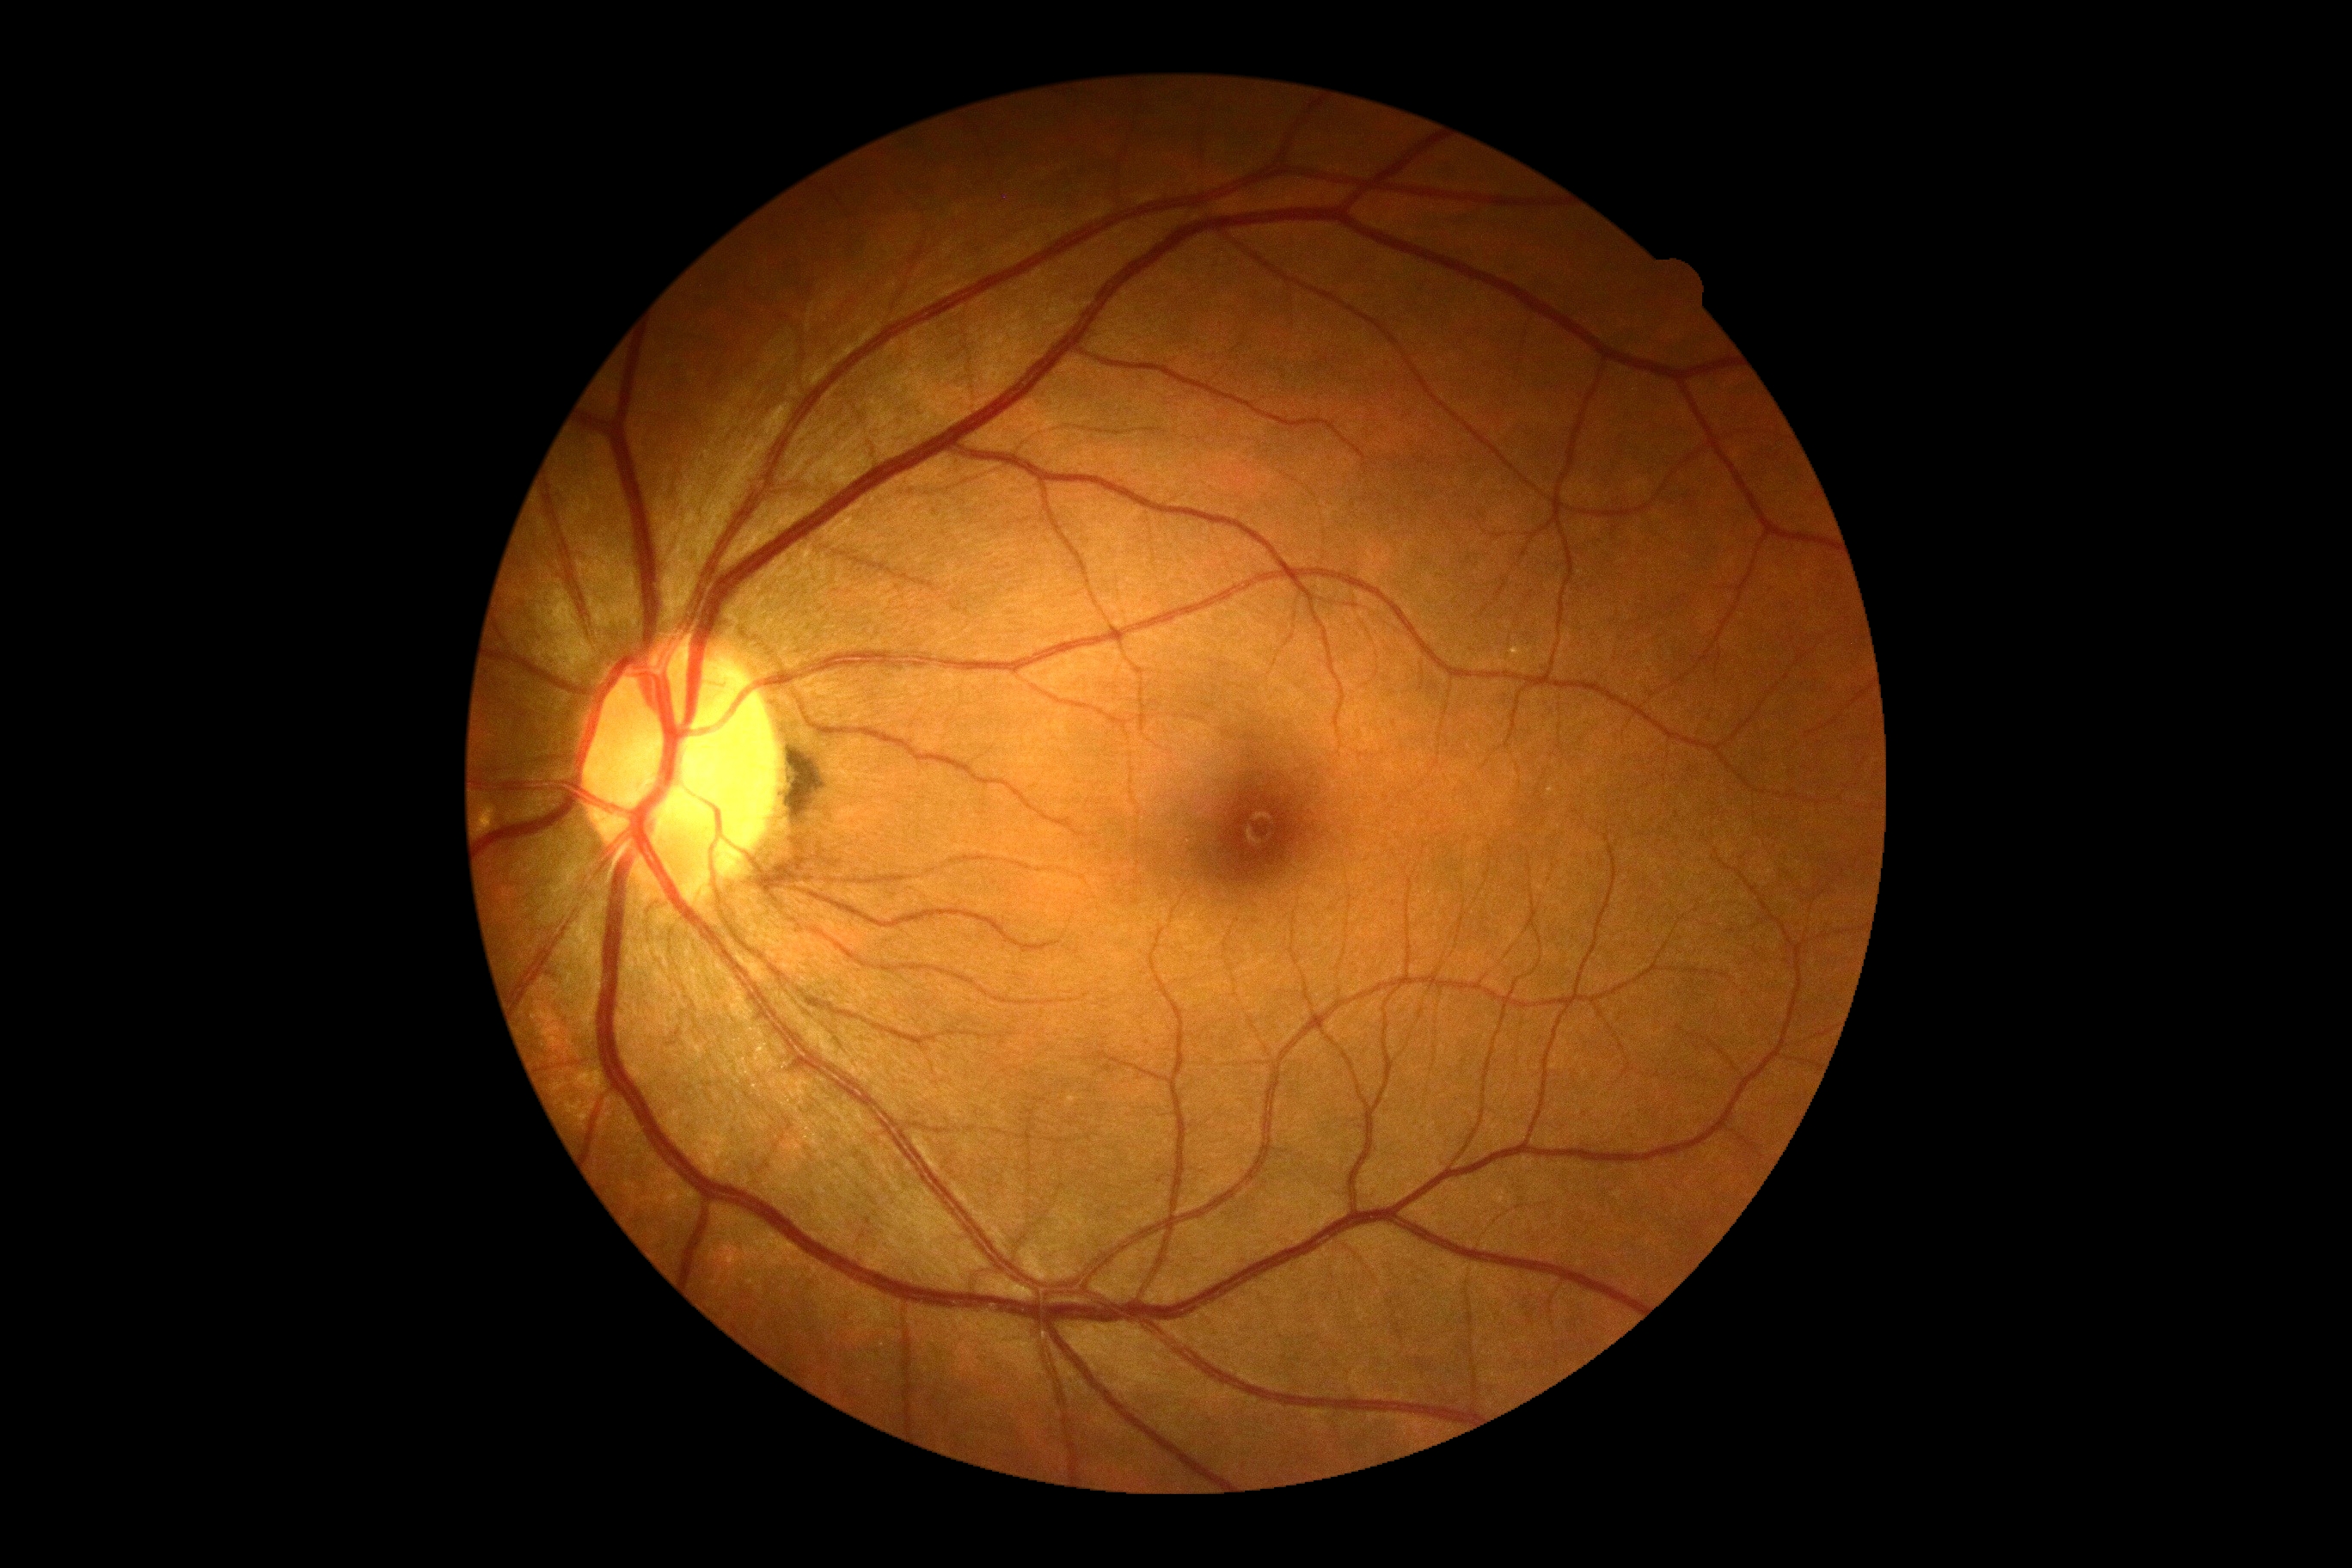

DR=grade 0 (no apparent retinopathy), DR impression=no apparent DR.